Captured on a Topcon TRC-NW400 fundus camera · 2212 by 1661 pixels · color fundus image — 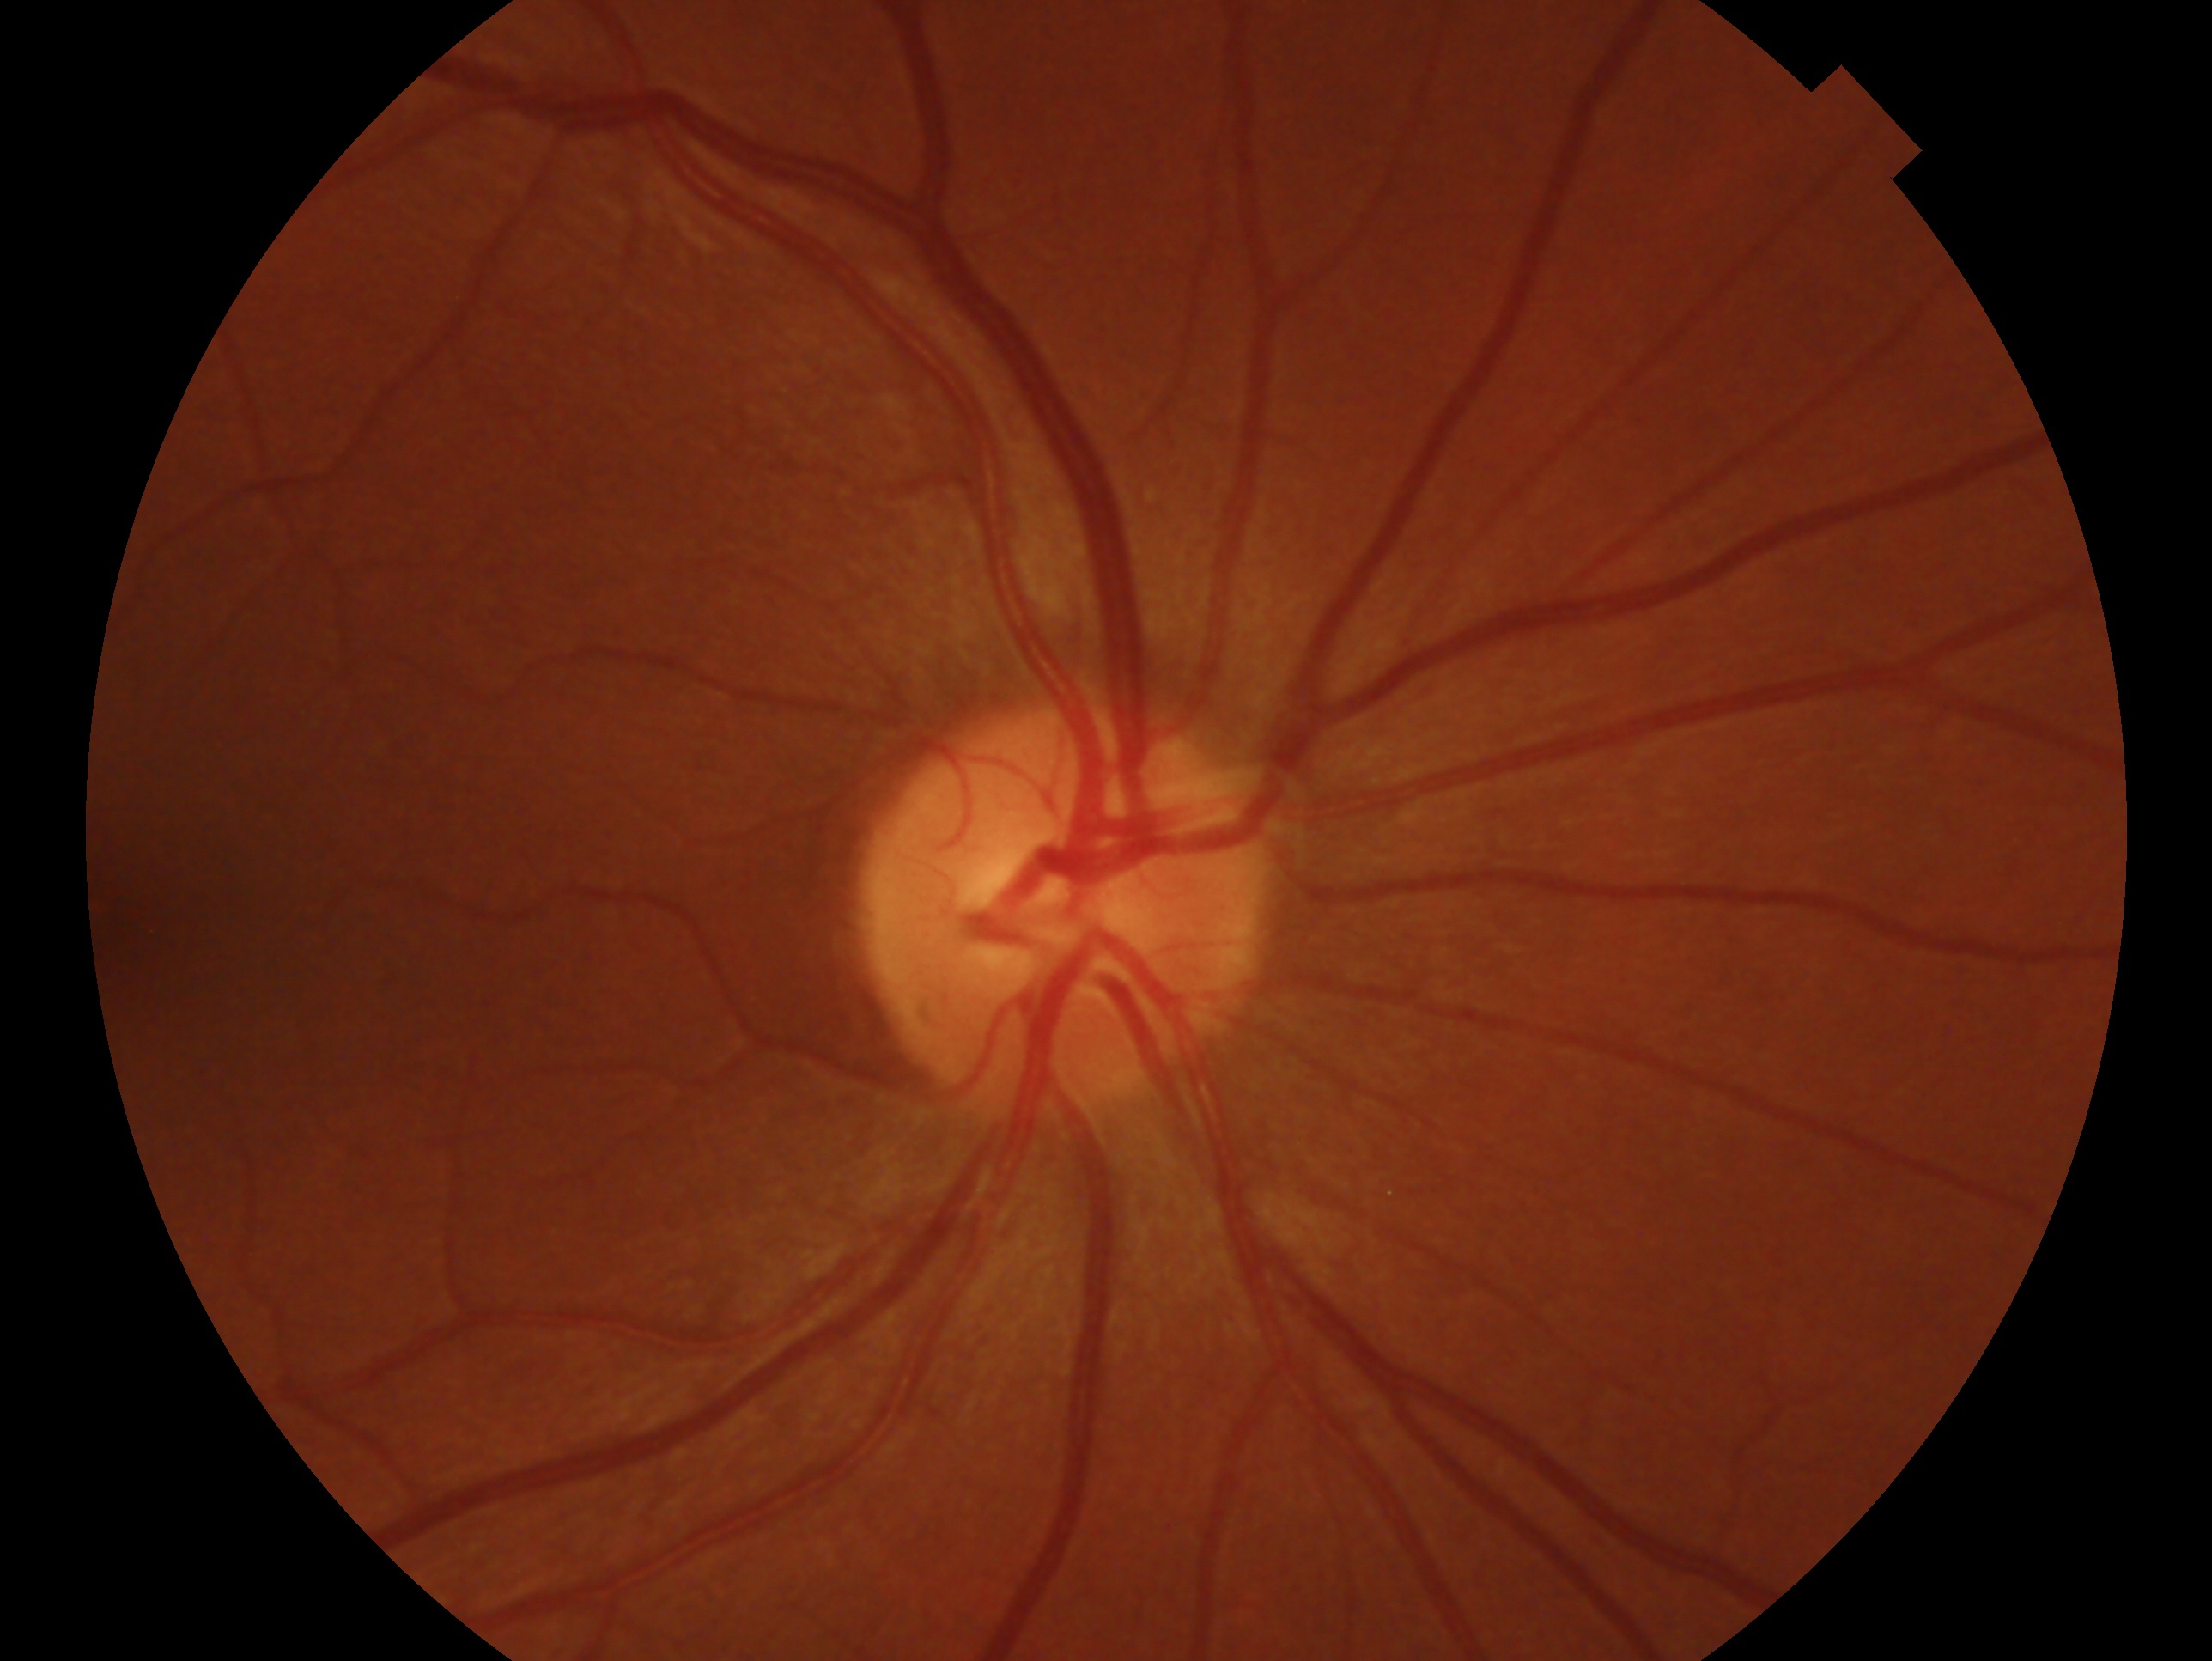 Imaged eye: oculus dexter. Clinical classification: no glaucomatous findings.